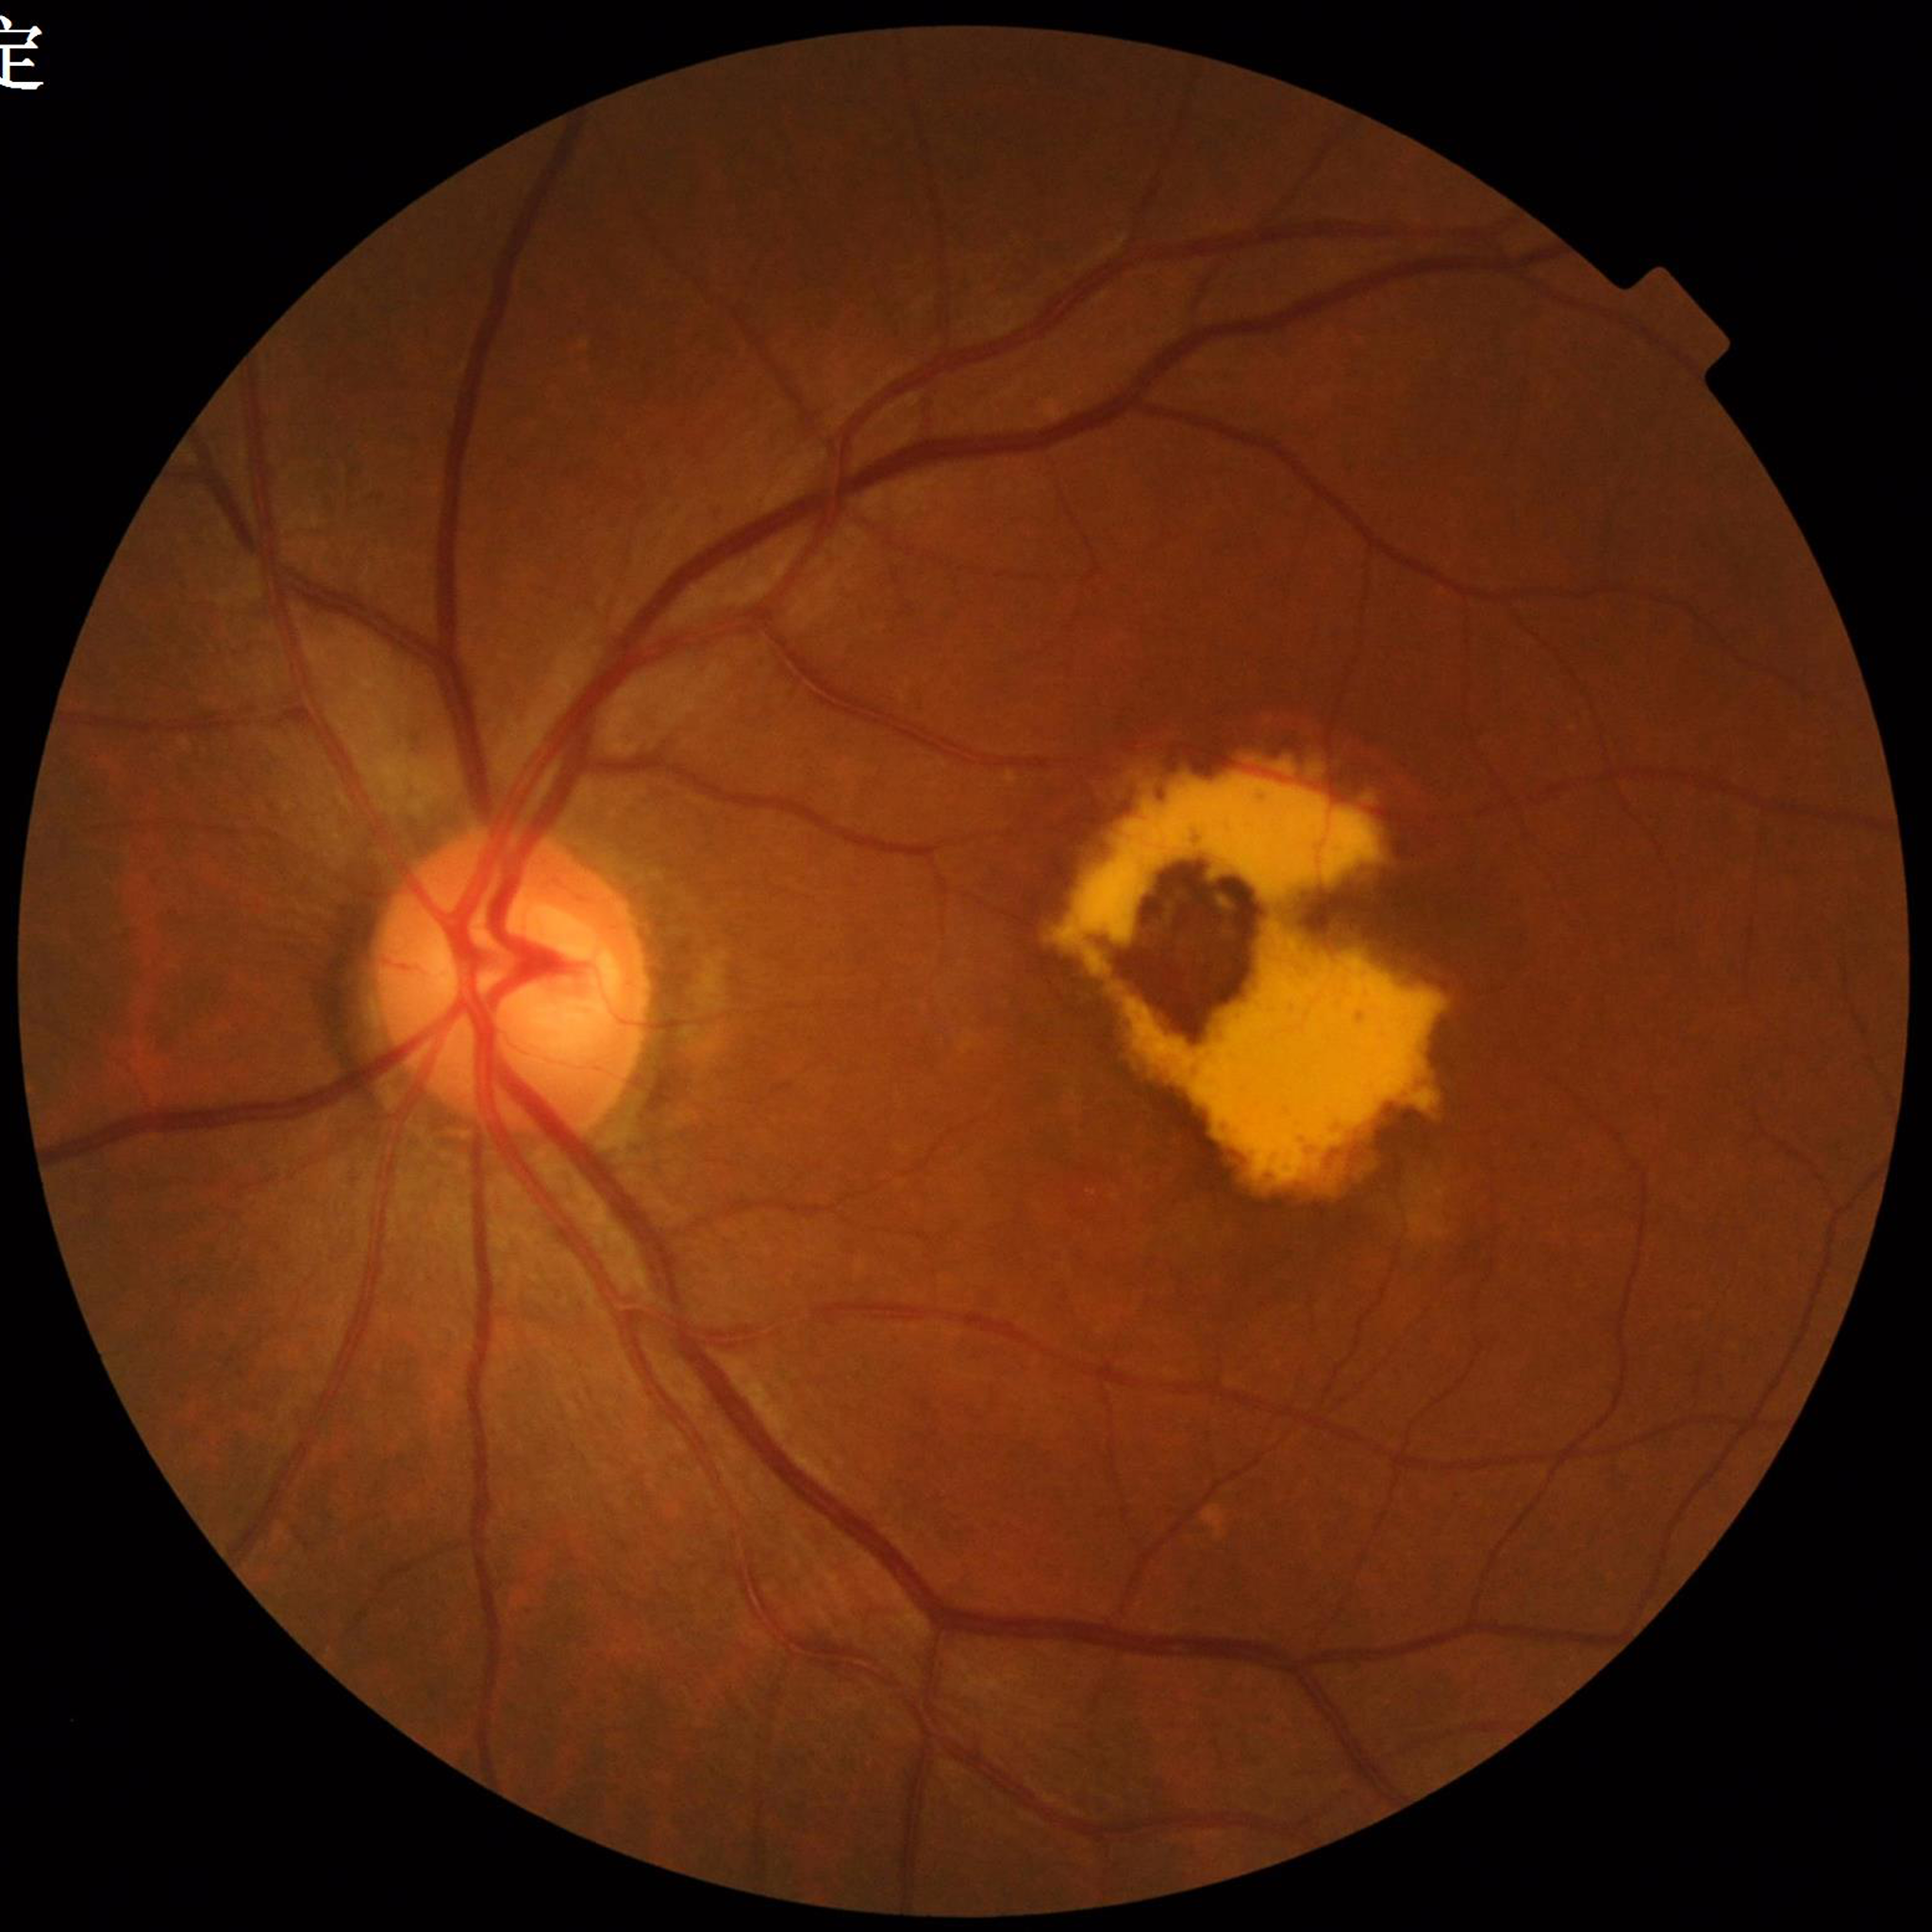

Eye affected by AMD.